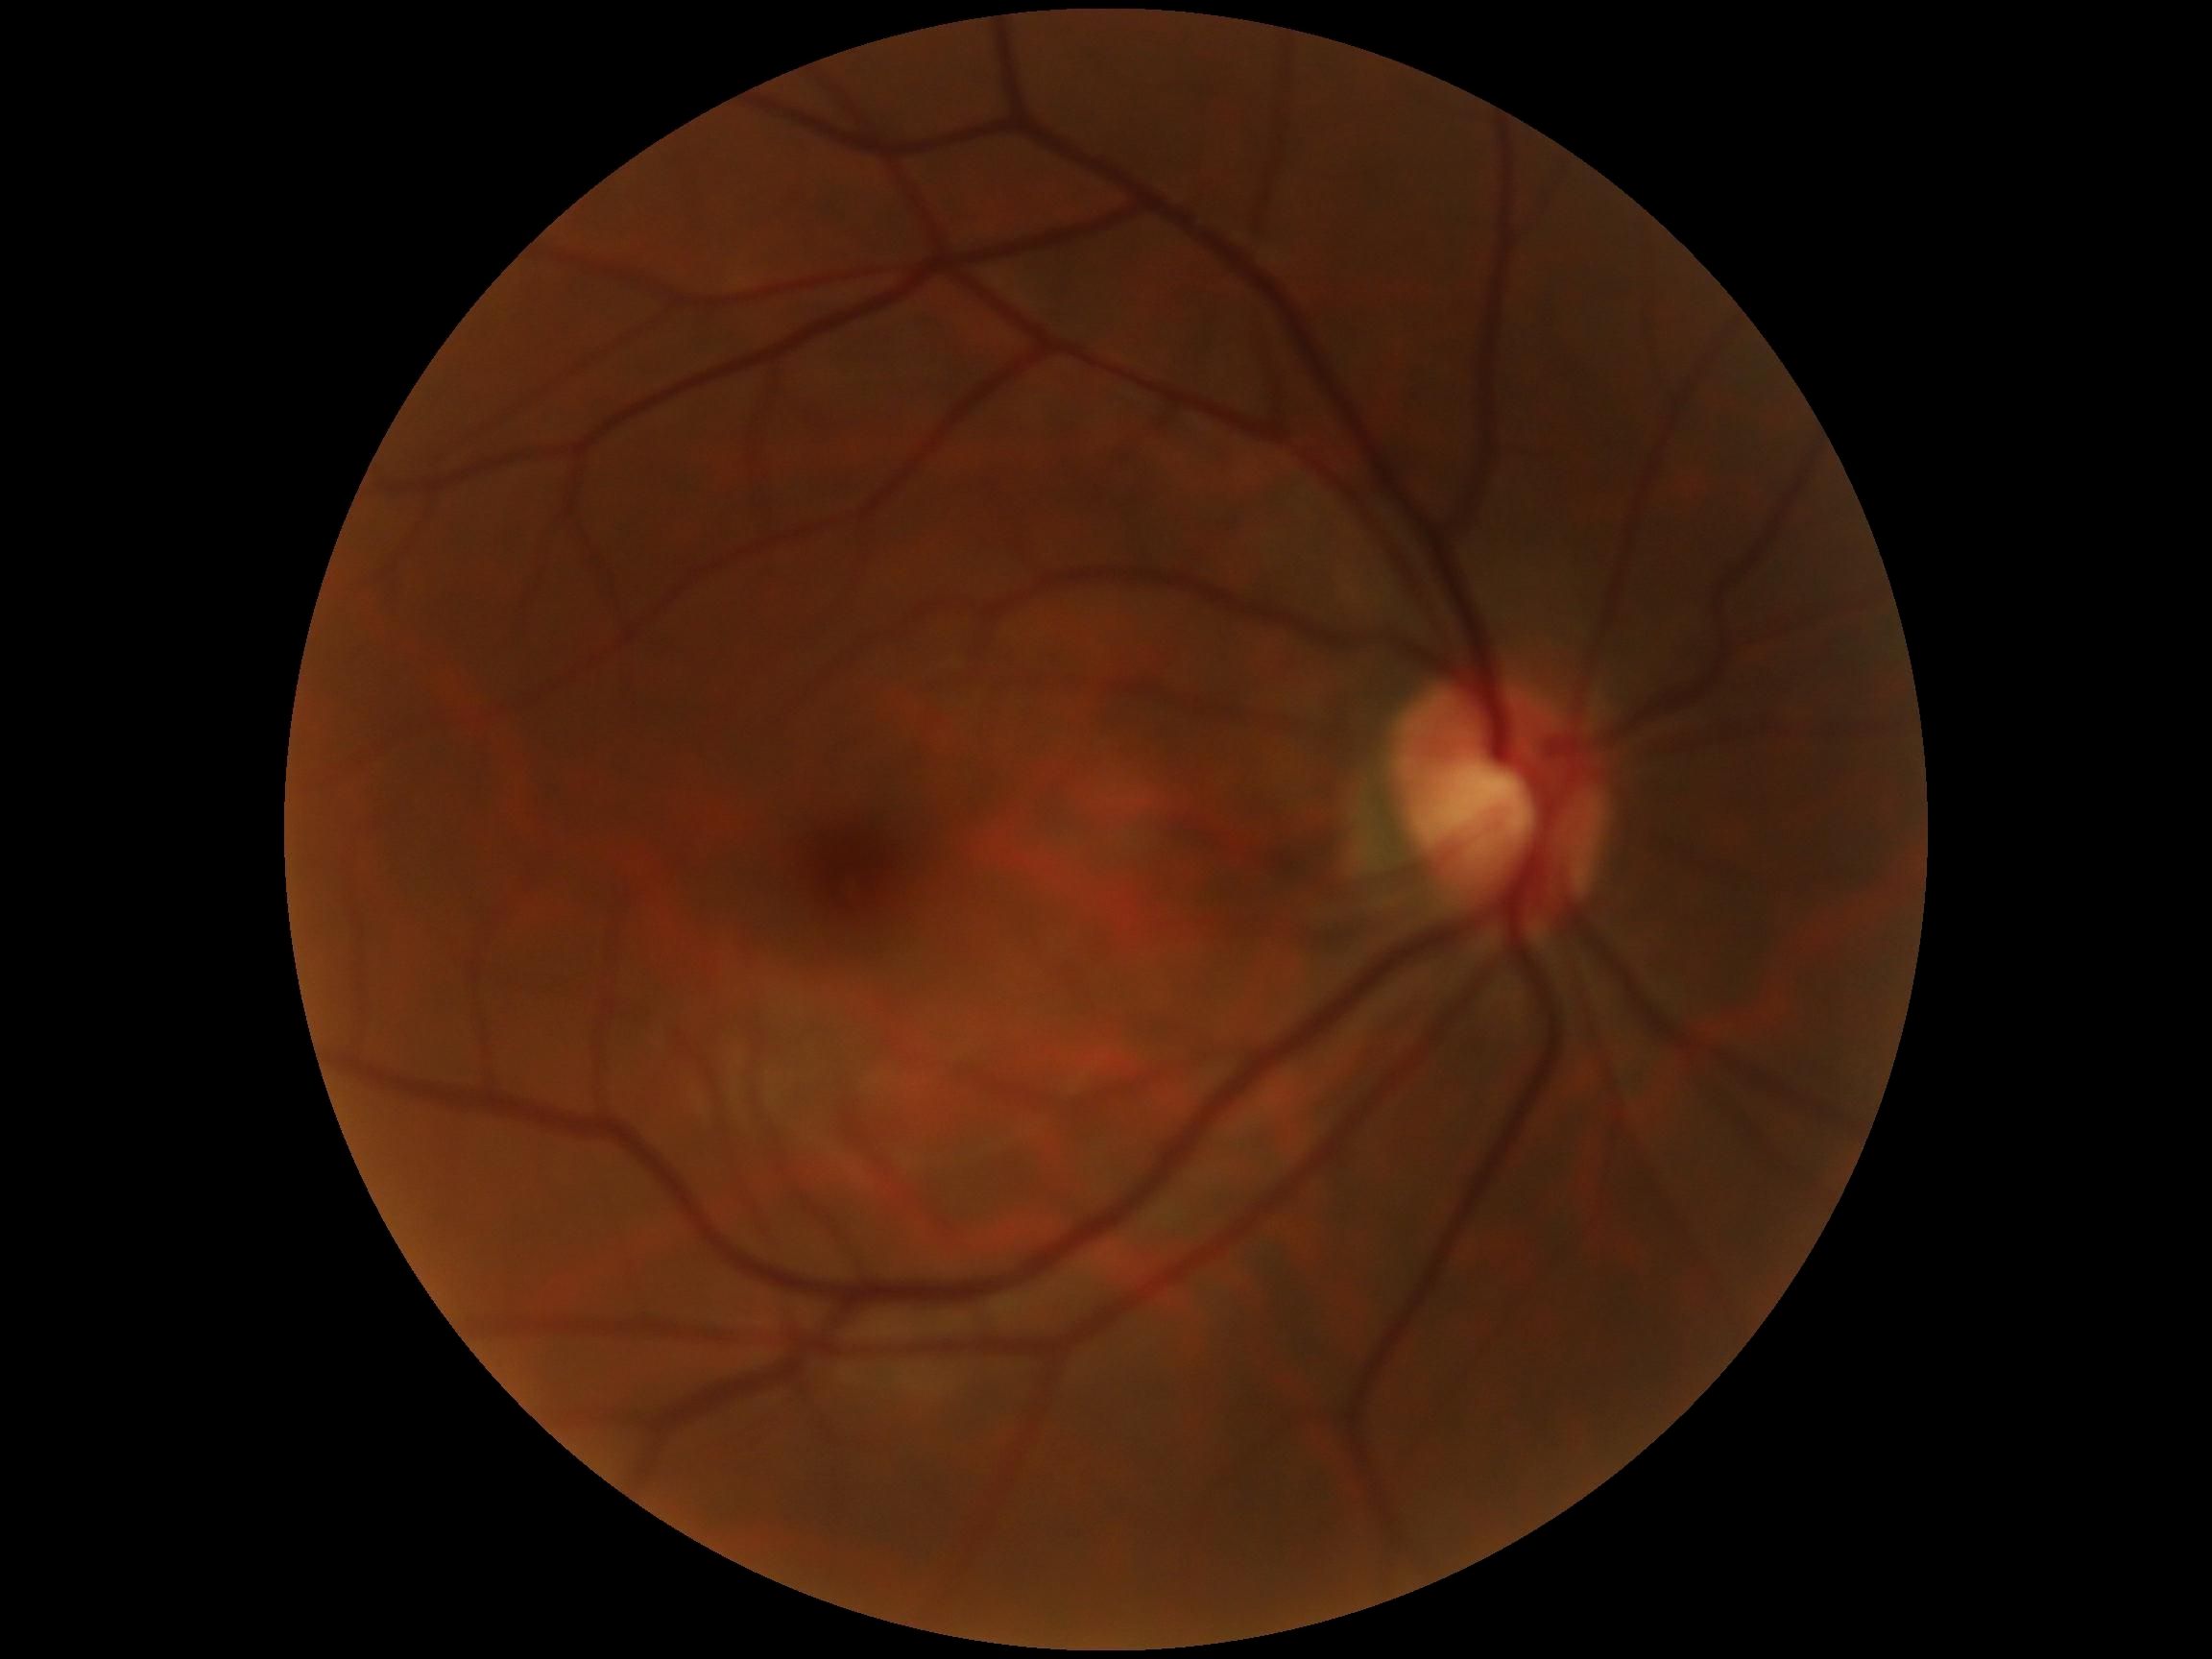
Diabetic retinopathy (DR): grade 0 (no apparent retinopathy).